848 x 848 pixels; nonmydriatic:
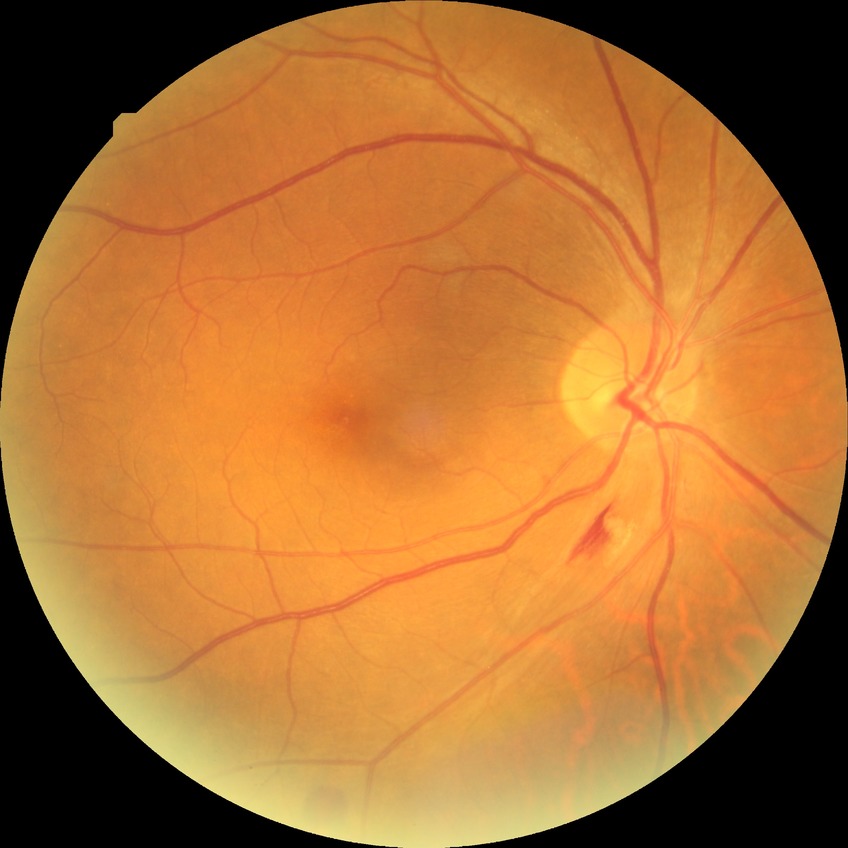 Diabetic retinopathy (DR) is simple diabetic retinopathy (SDR).